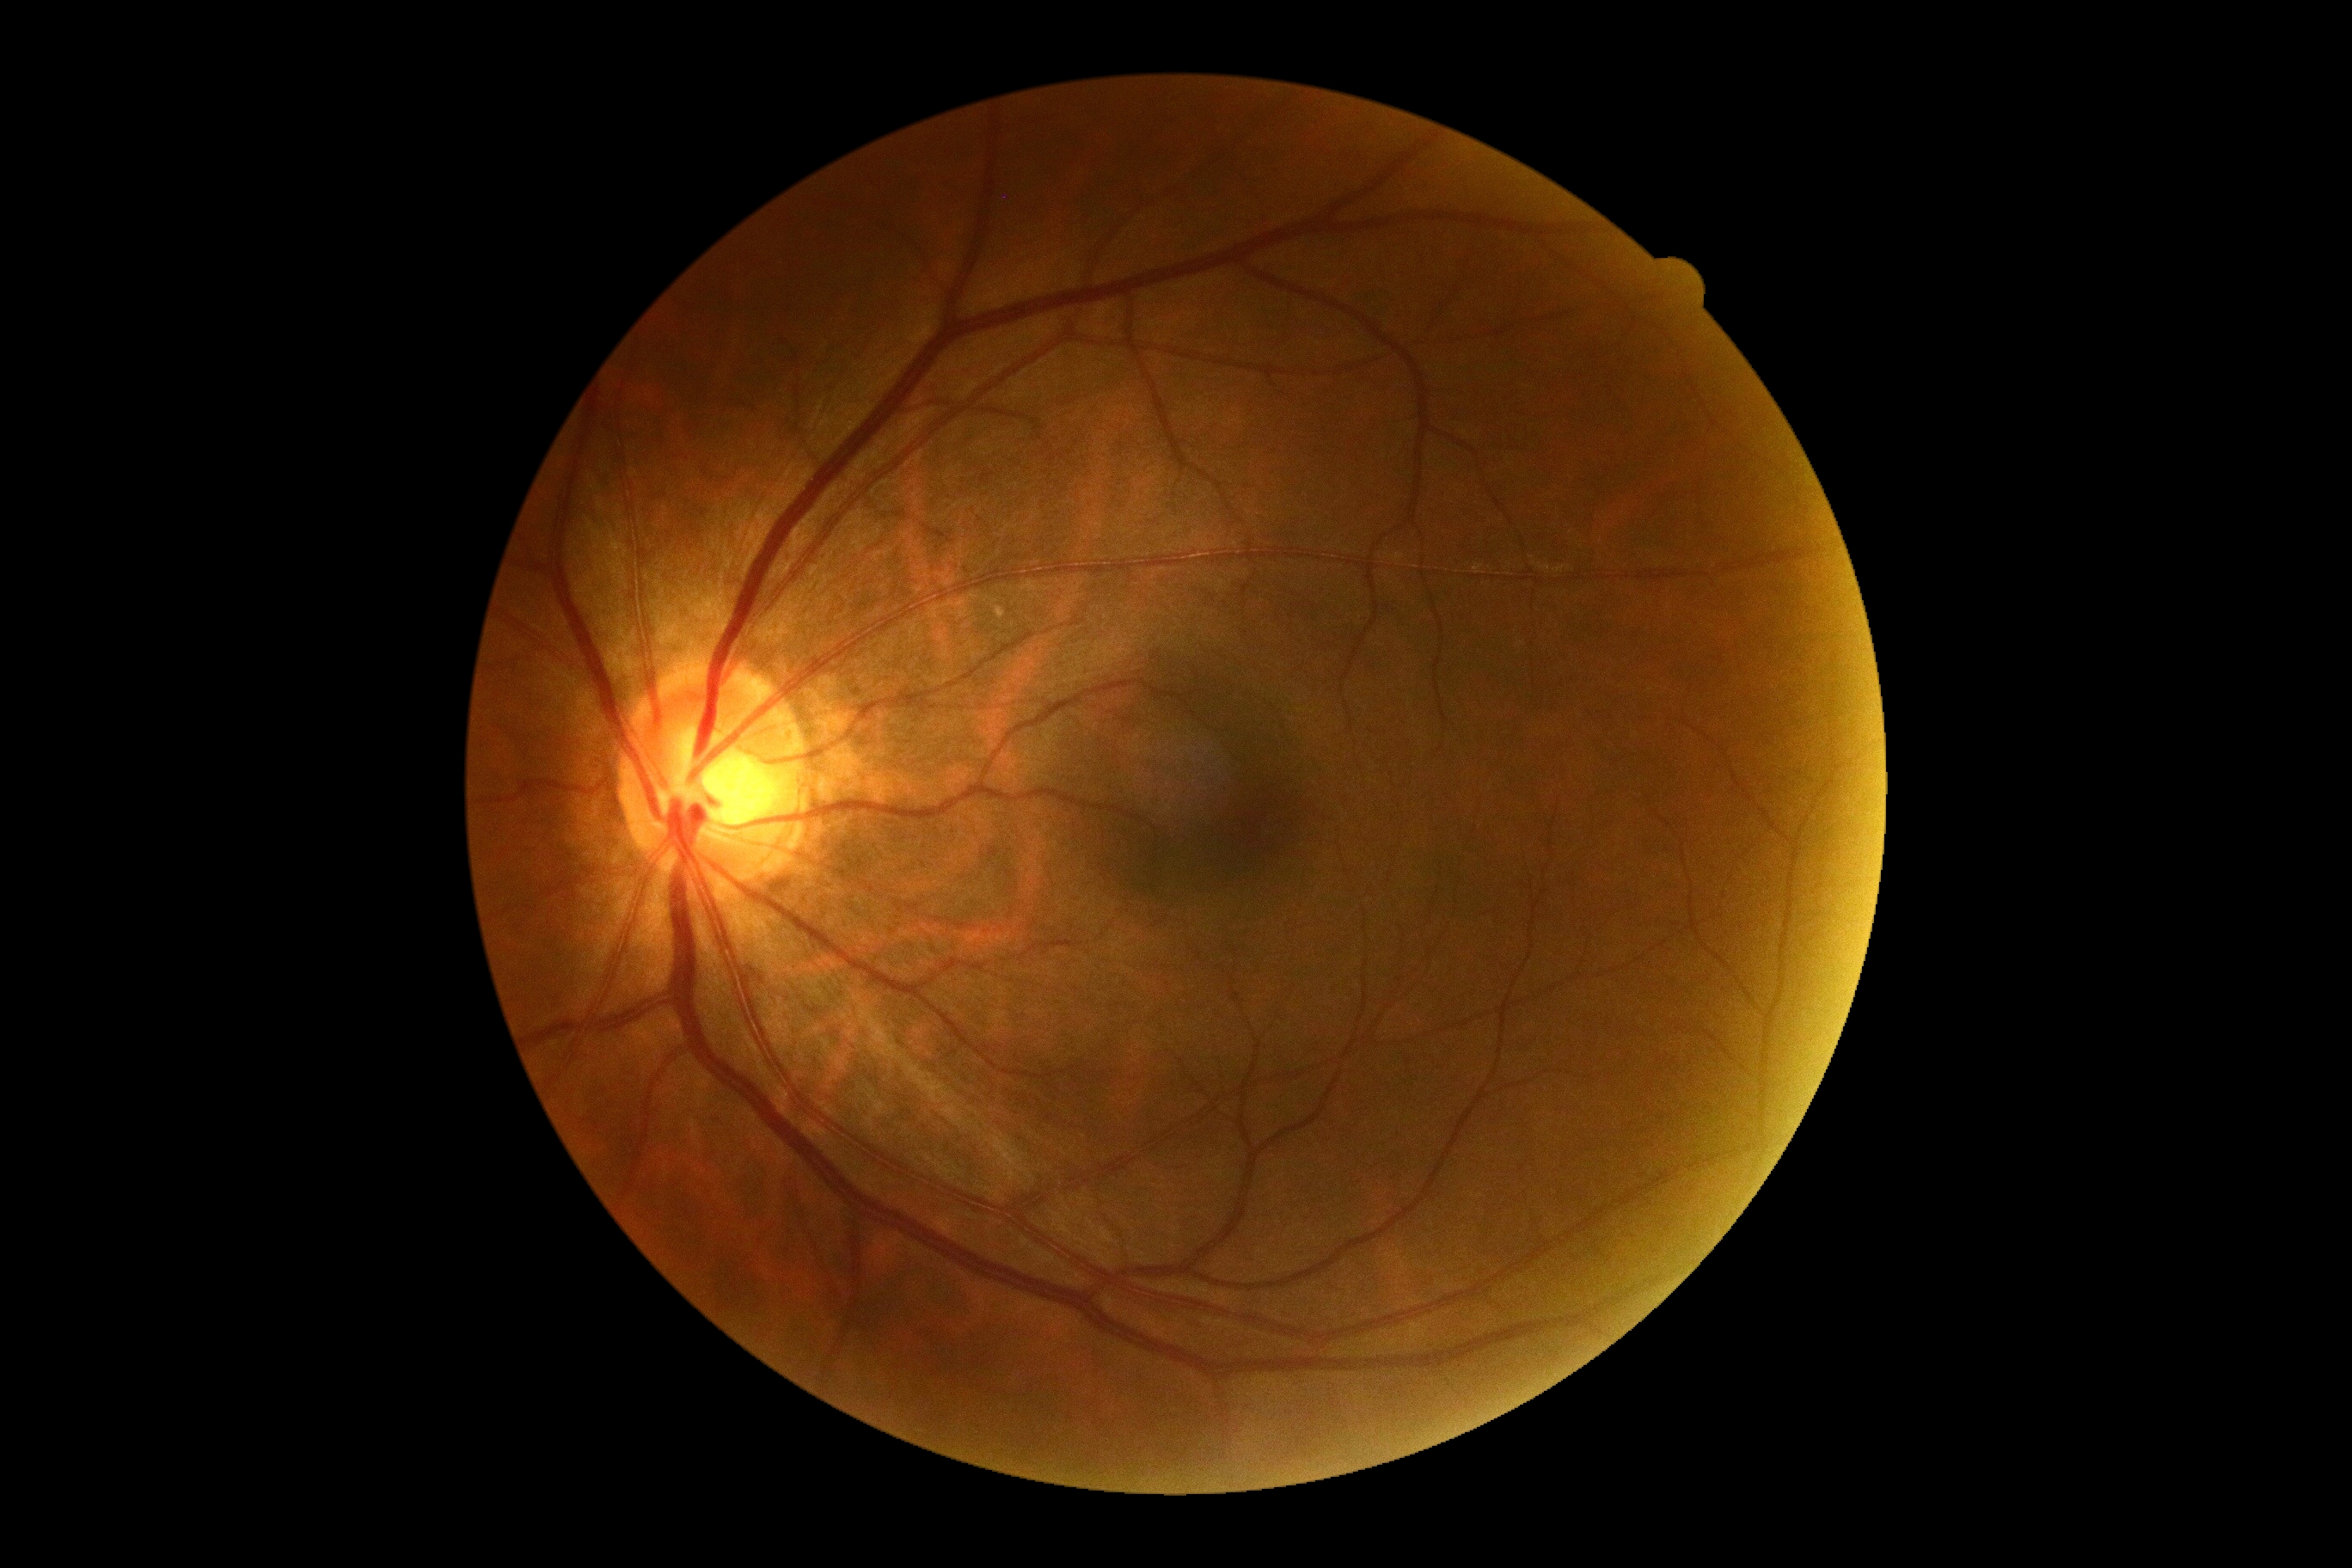
No diabetic retinal disease findings. Diabetic retinopathy grade: 0.